Wide-field contact fundus photograph of an infant; 100° field of view (Phoenix ICON); 1240 by 1240 pixels: 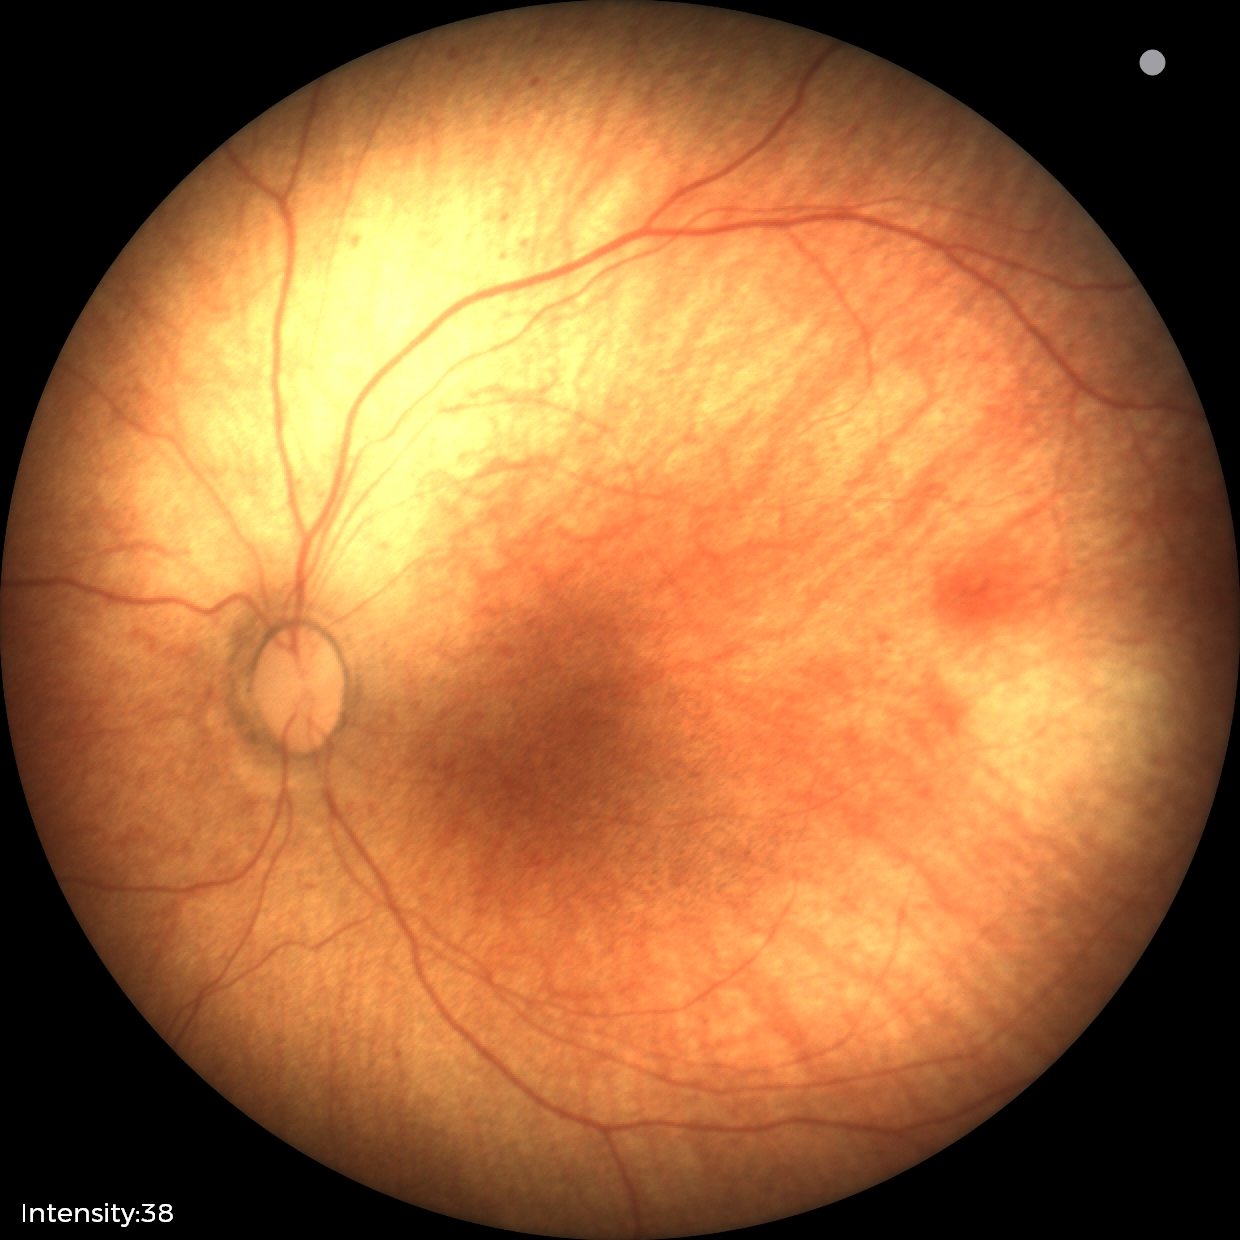
Screening: normal retinal appearance.